Wide-field contact fundus photograph of an infant — 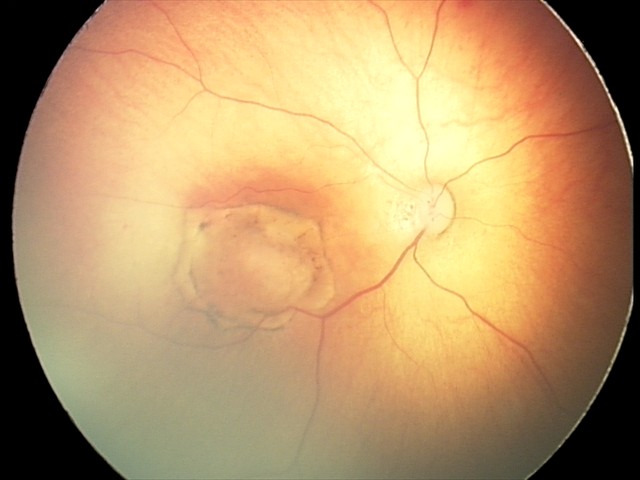

Series diagnosed as toxoplasmosis chorioretinitis.